1624 by 1232 pixels, color fundus photograph
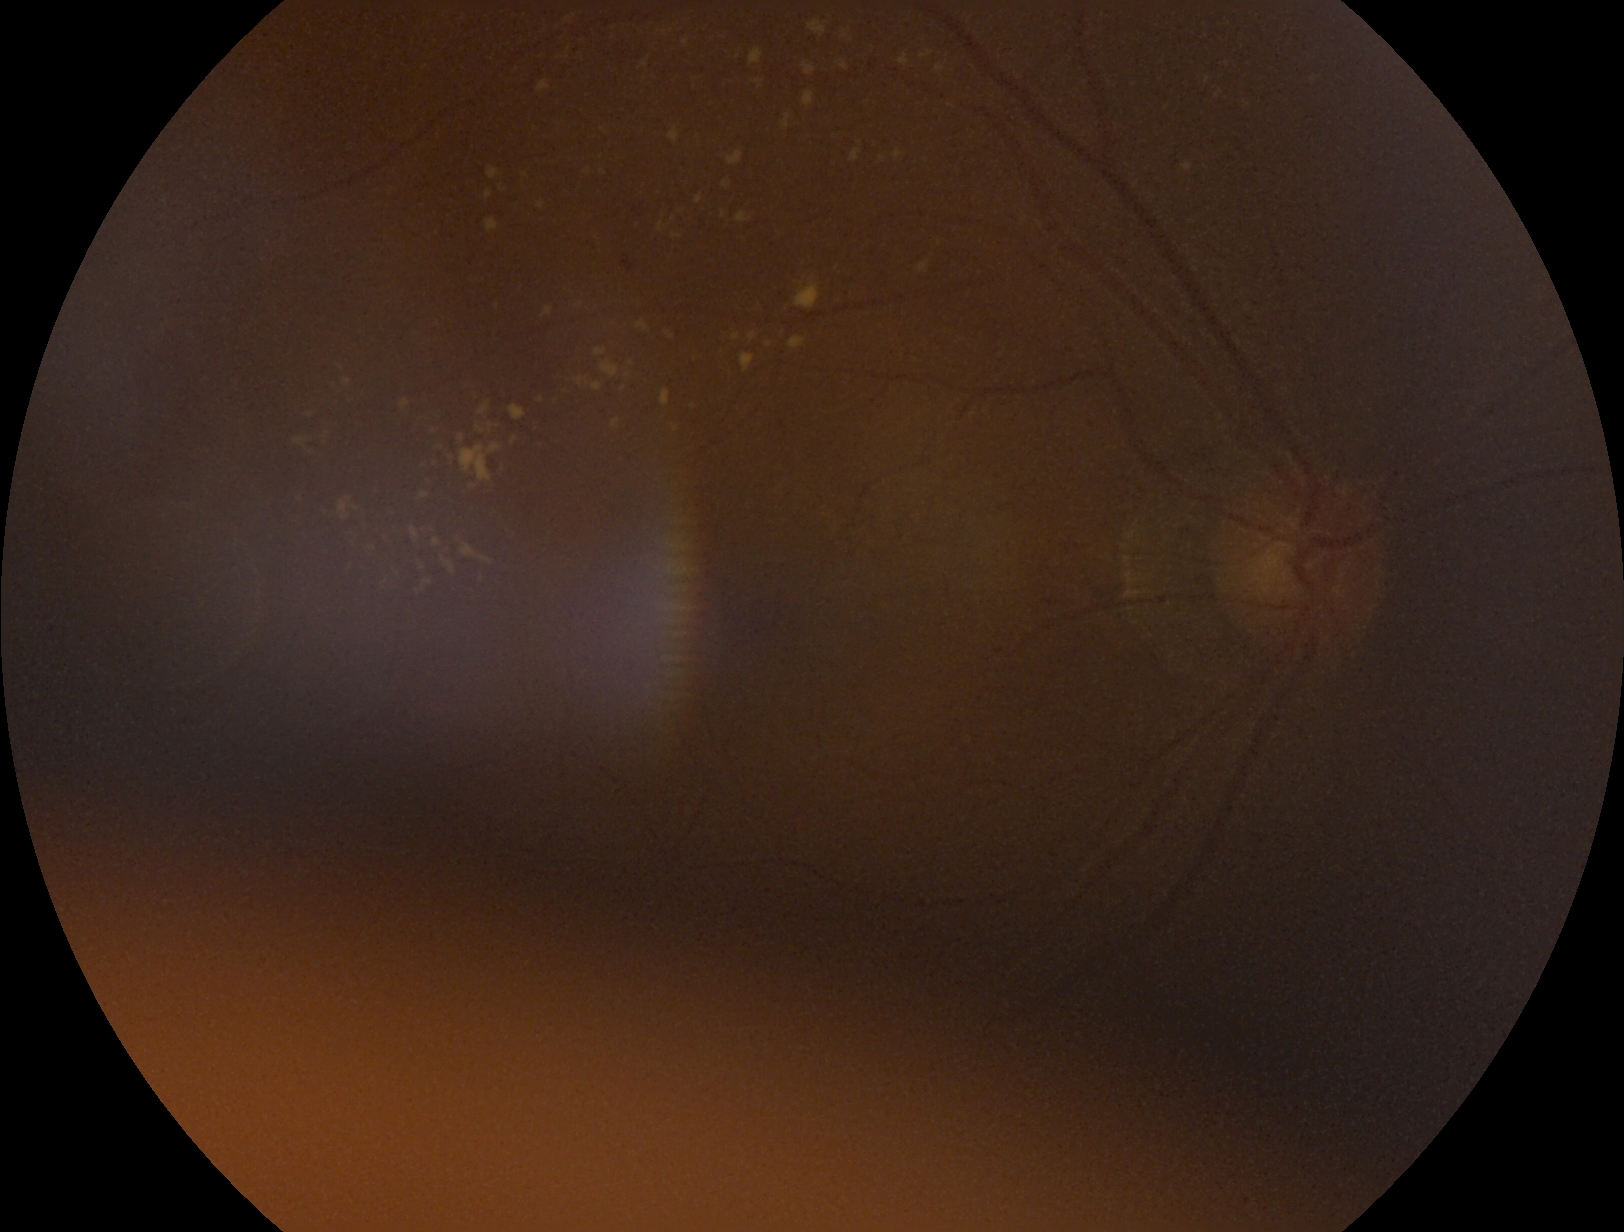

diabetic retinopathy (DR)=grade 2 (moderate NPDR).